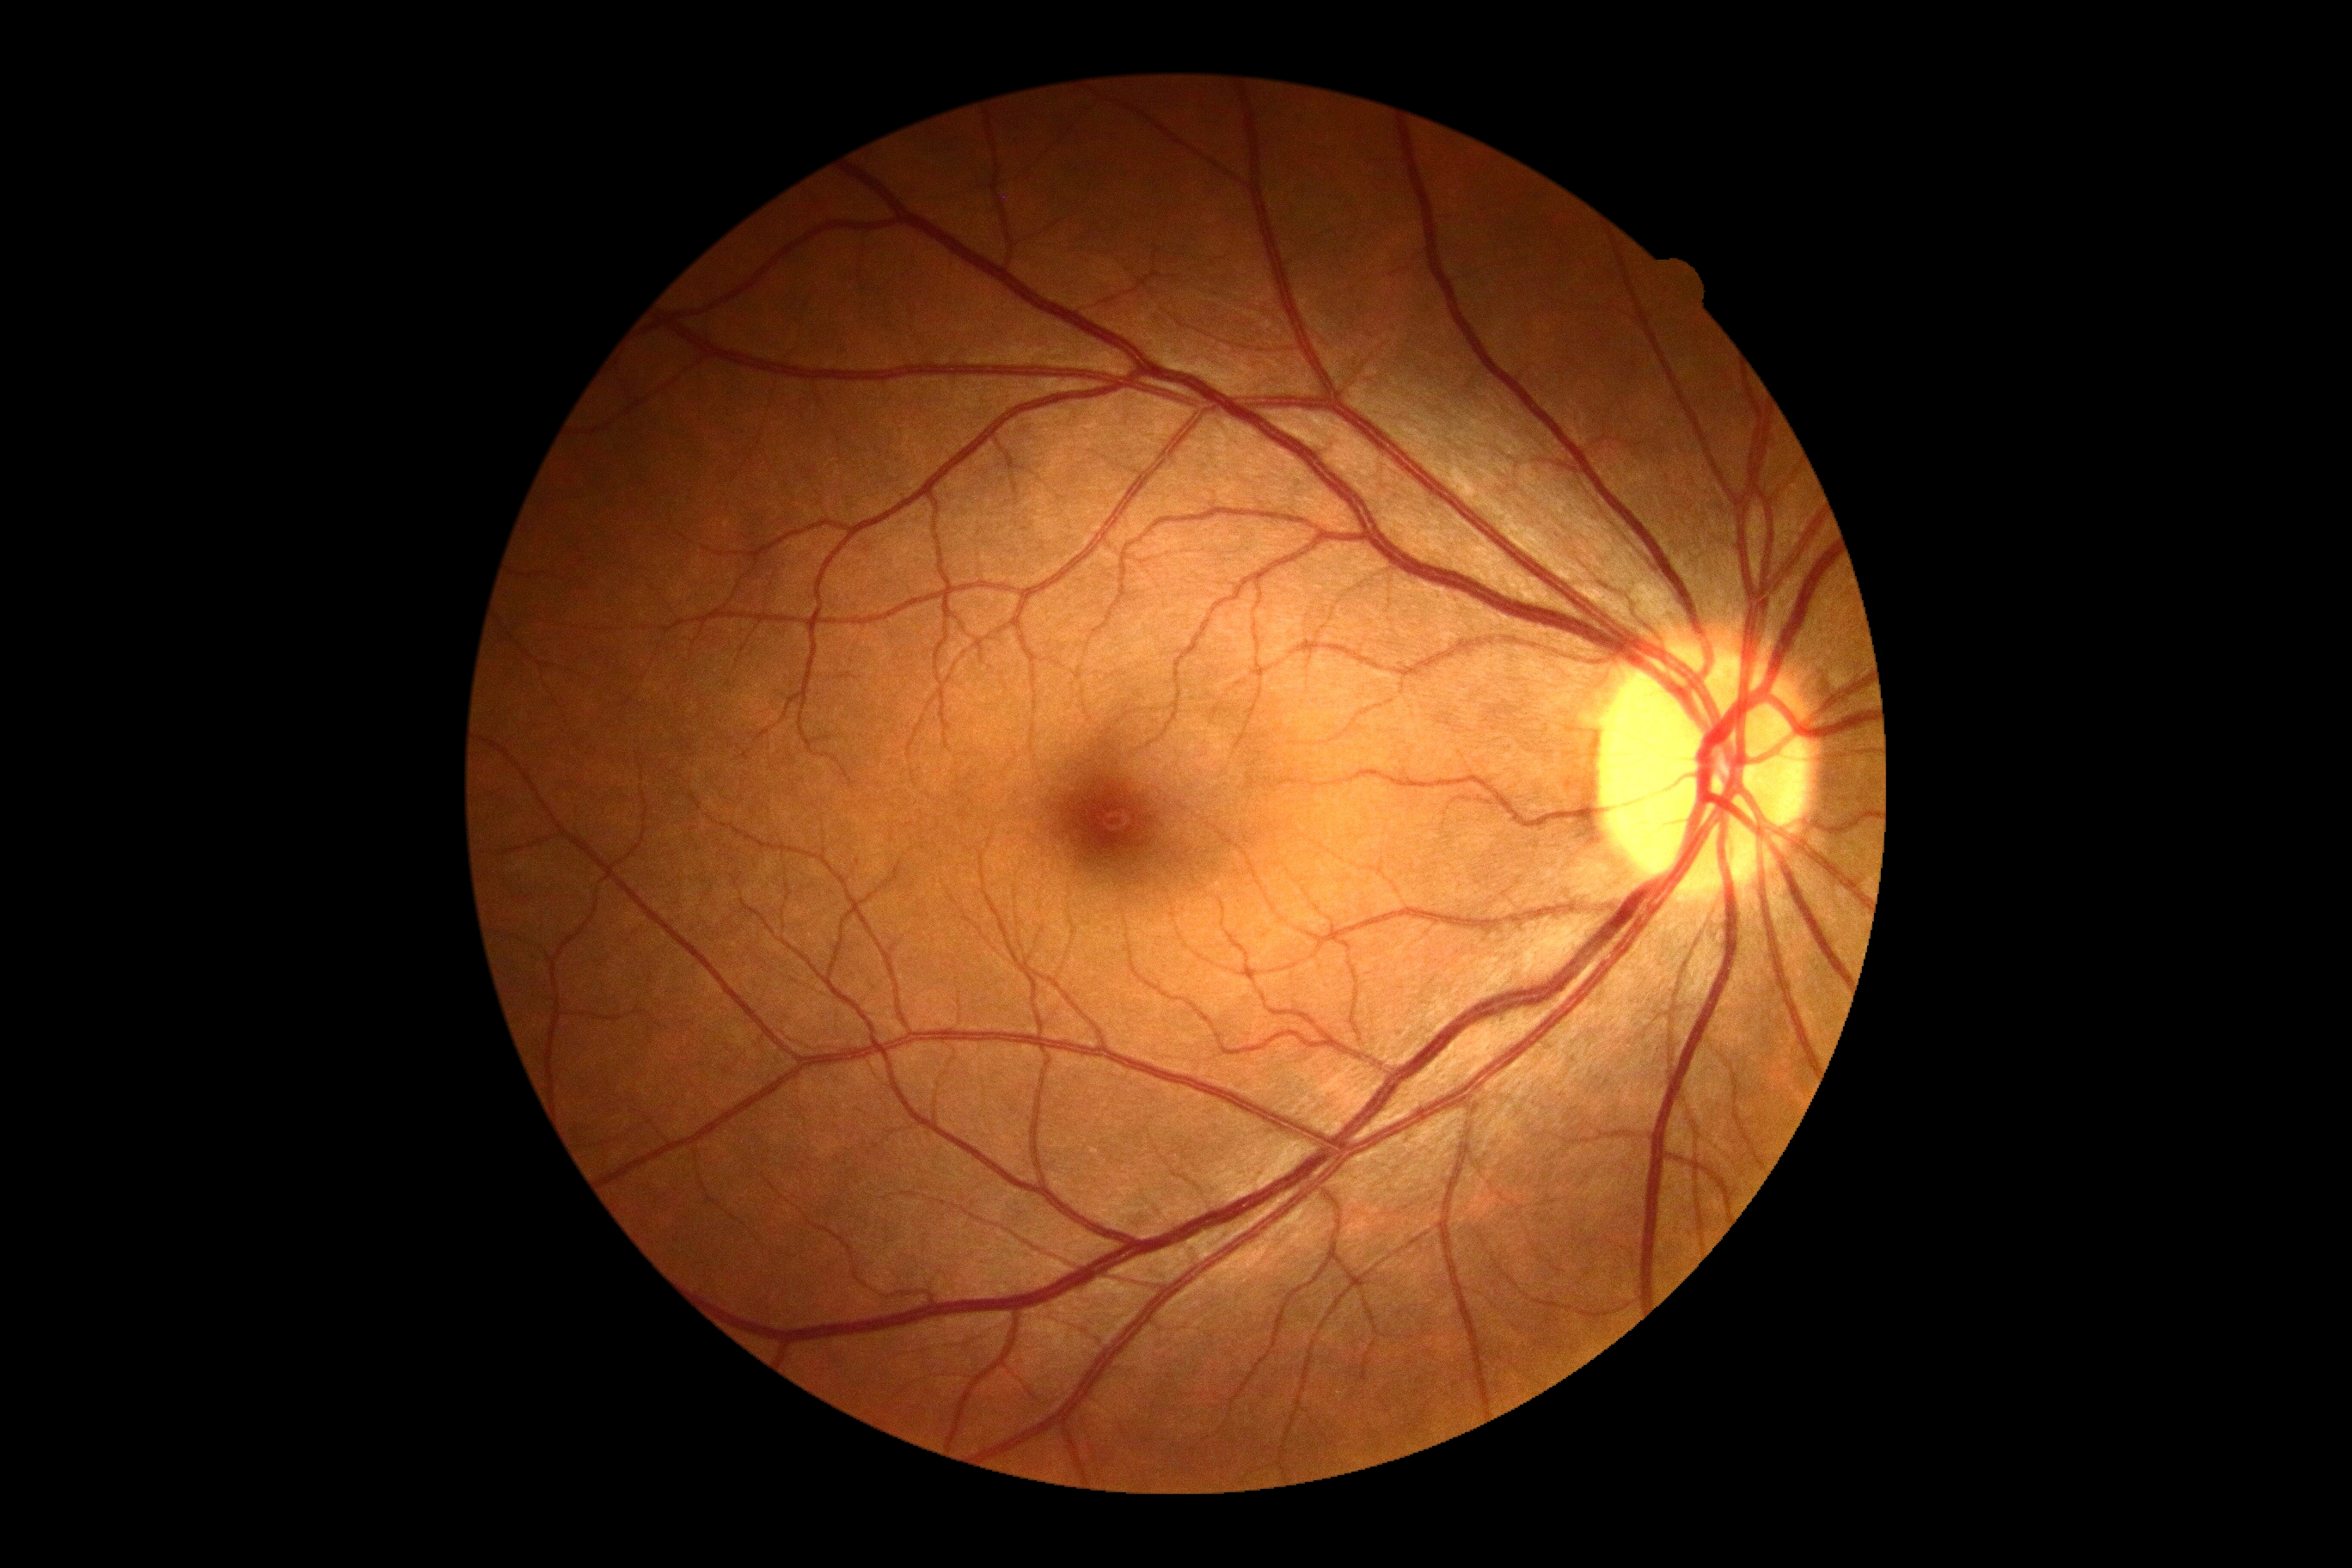
DR is grade 0.